NIDEK AFC-230 — 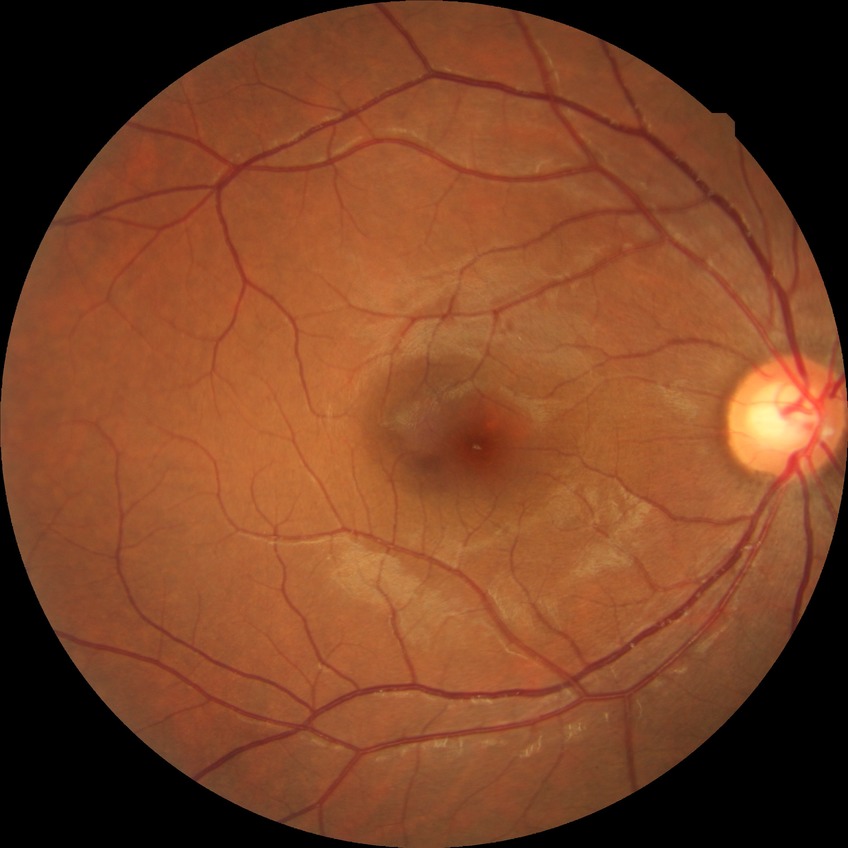
Diabetic retinopathy (DR): no diabetic retinopathy (NDR).